Nonmydriatic fundus photograph. 848x848. Fundus photo. 45 degree fundus photograph:
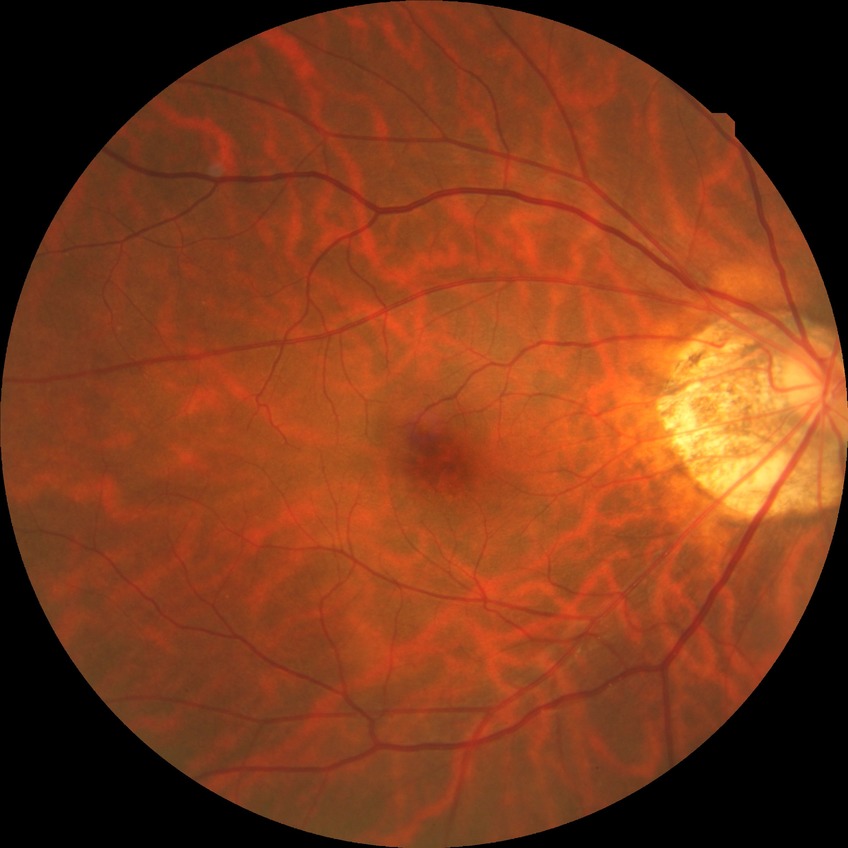
DR grade = NDR.